CFP.
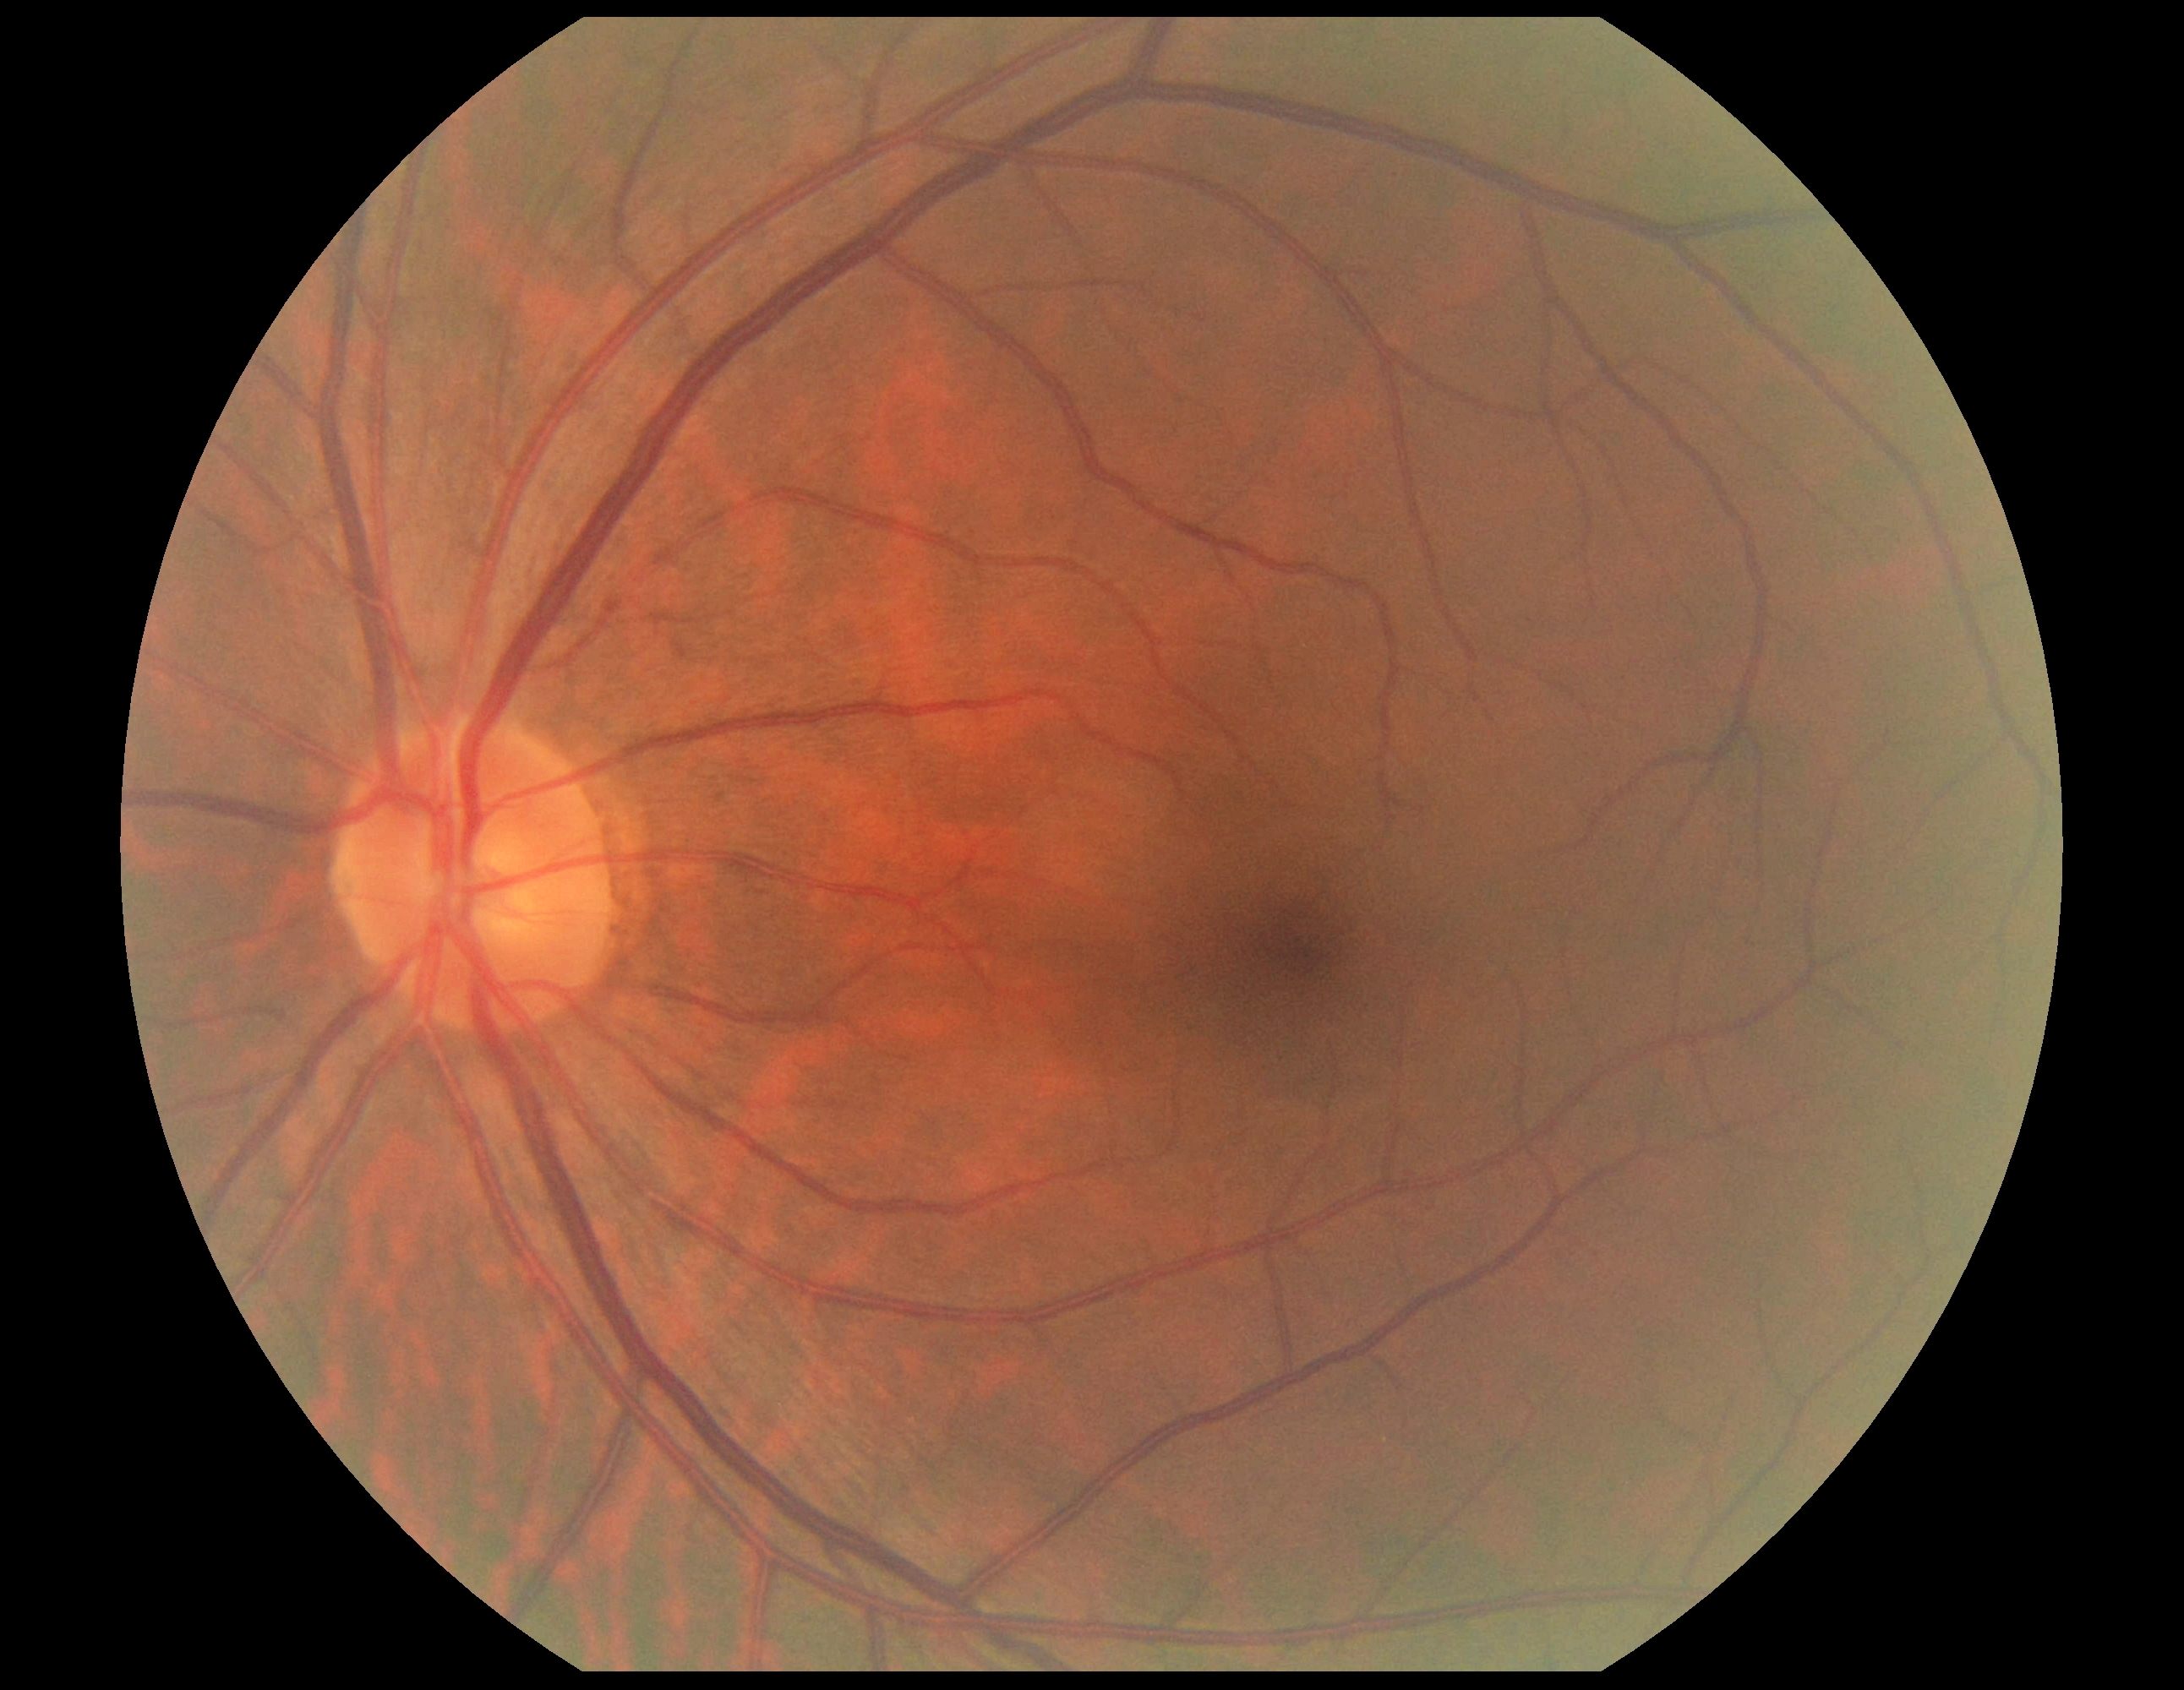

No signs of diabetic retinopathy. DR severity is 0.